45-degree field of view. Retinal fundus photograph.
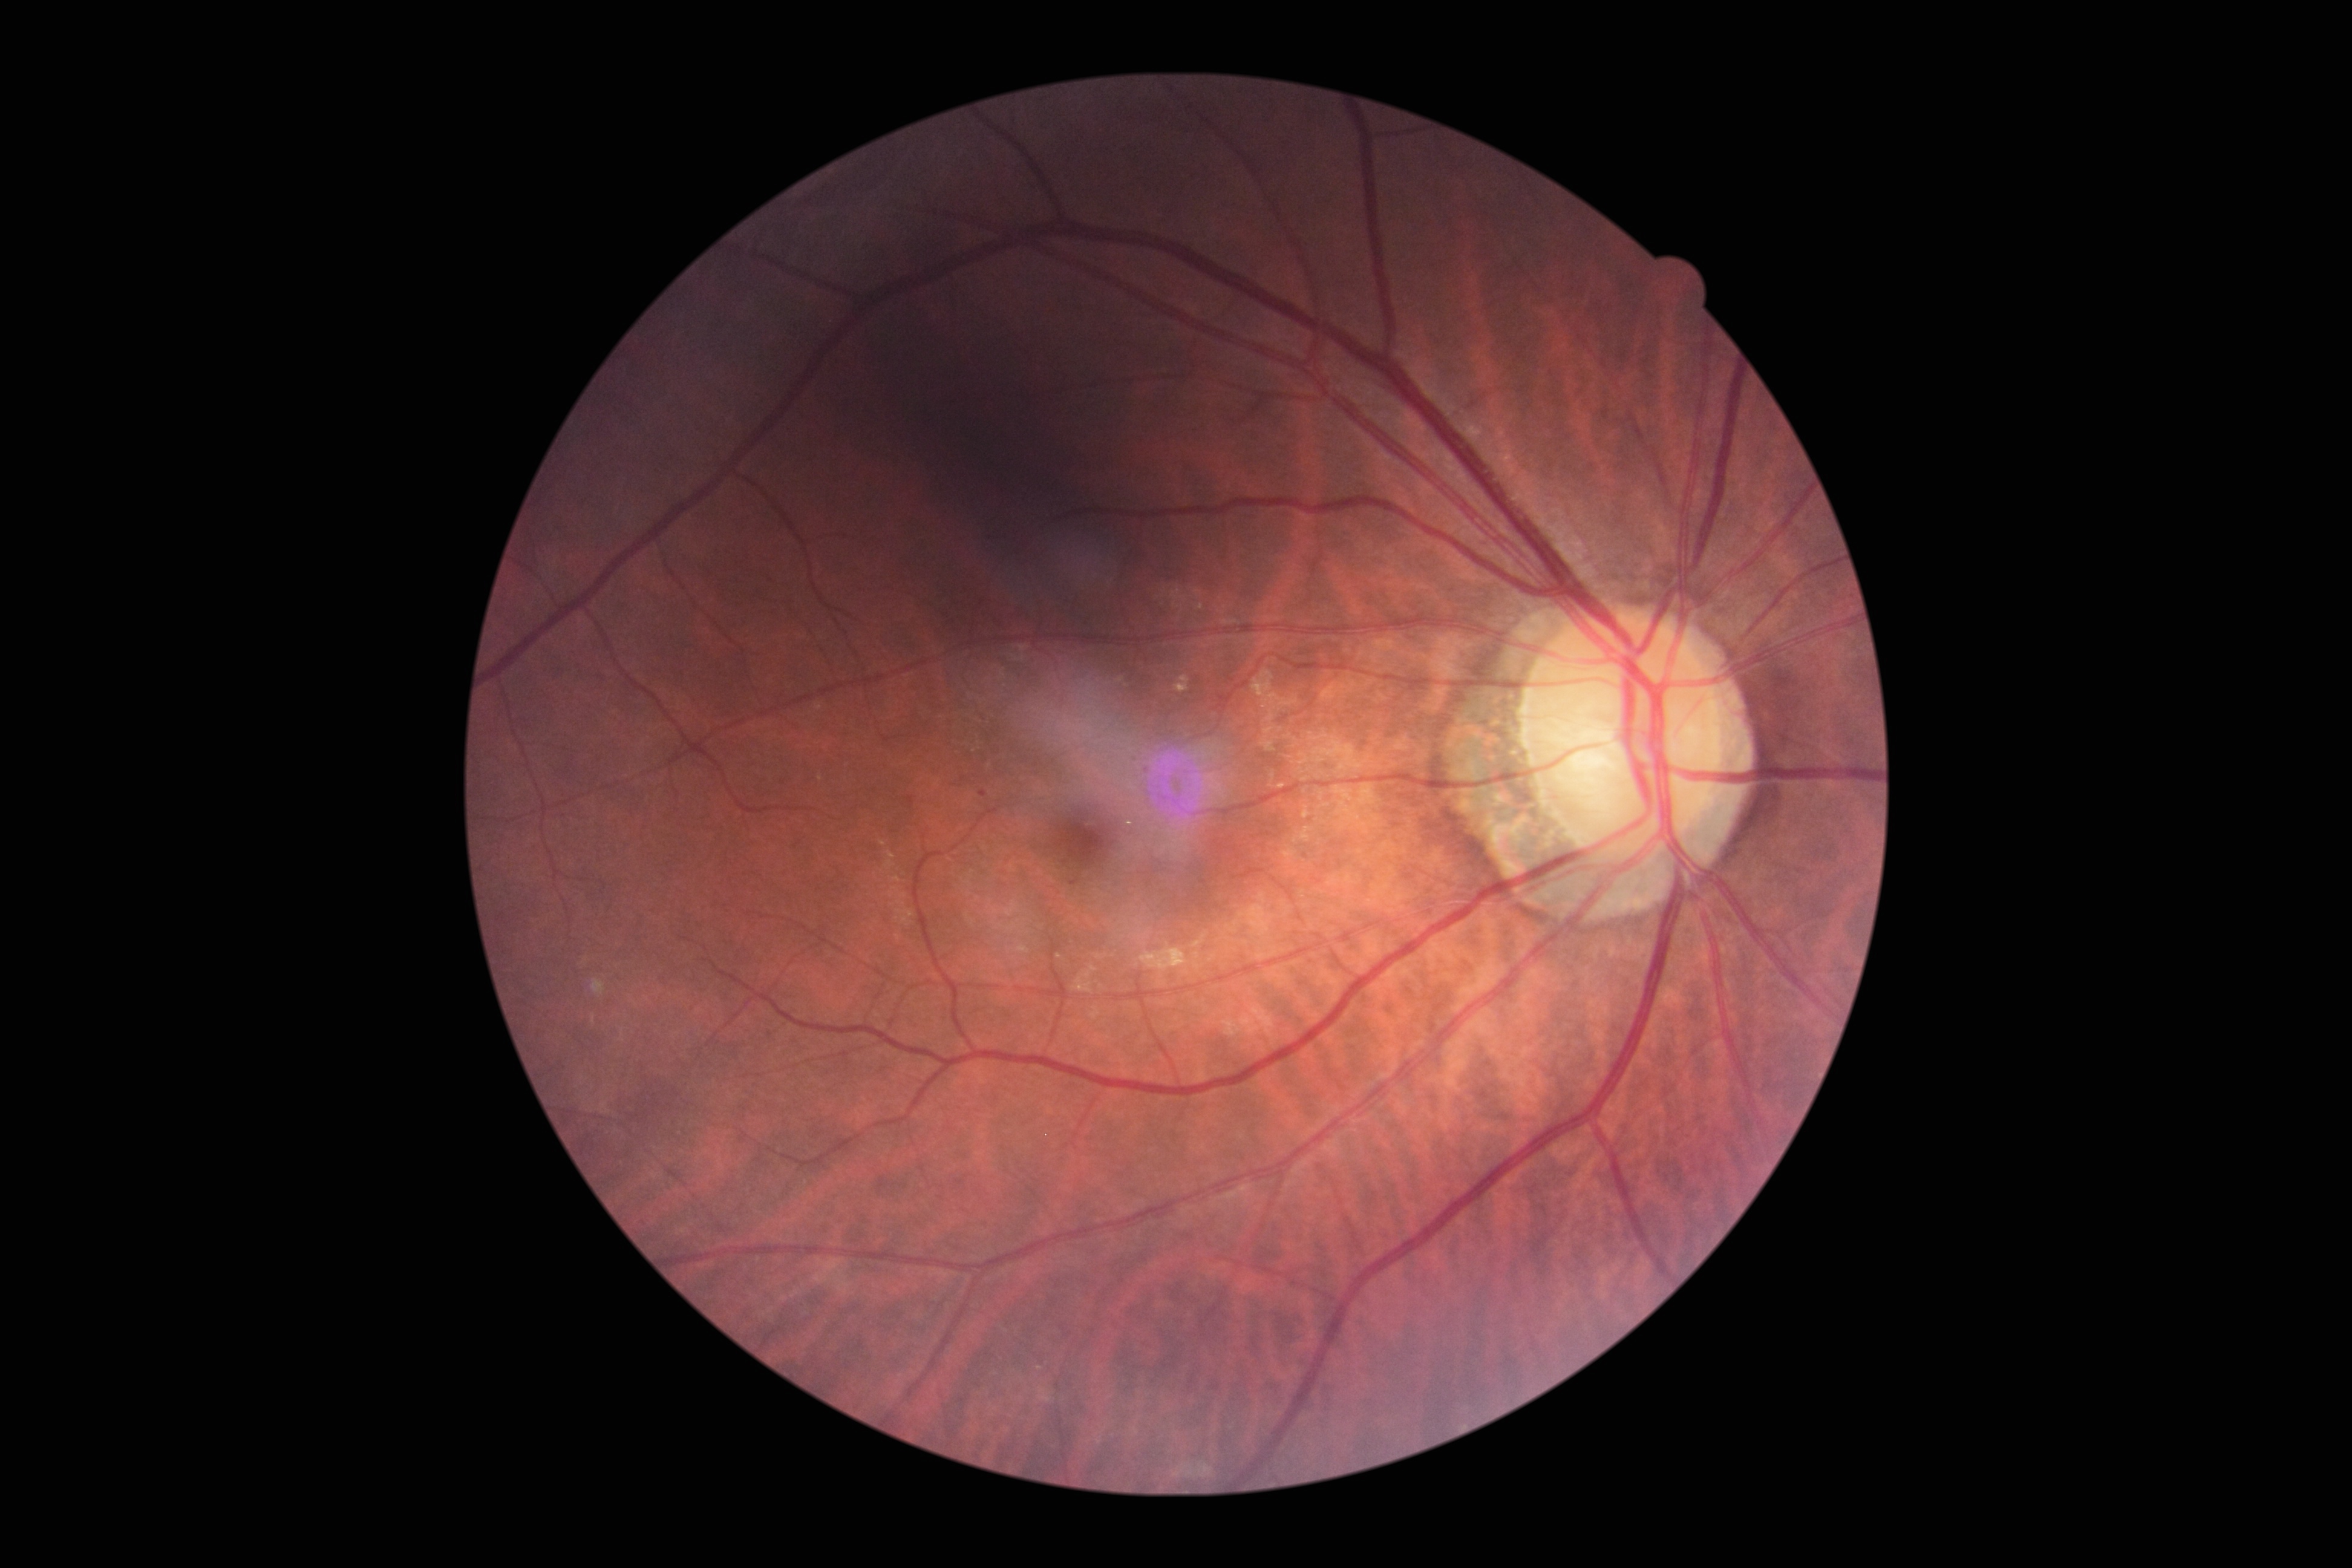 Diabetic retinopathy grade: moderate NPDR (2).